Captured with the Clarity RetCam 3 (130° field of view); RetCam wide-field infant fundus image:
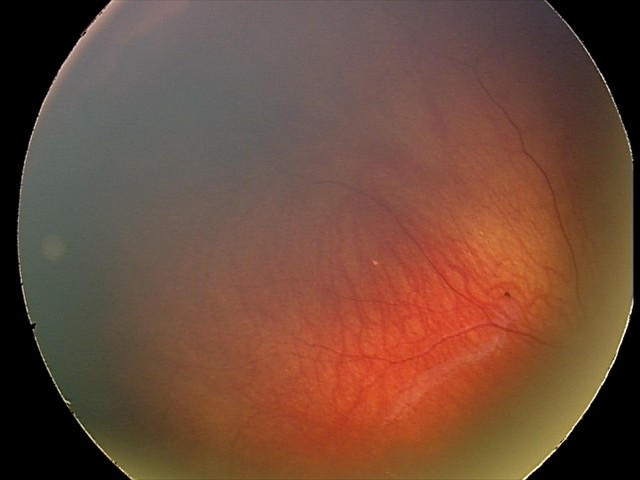
Assessment: retinal astrocytic hamartoma.